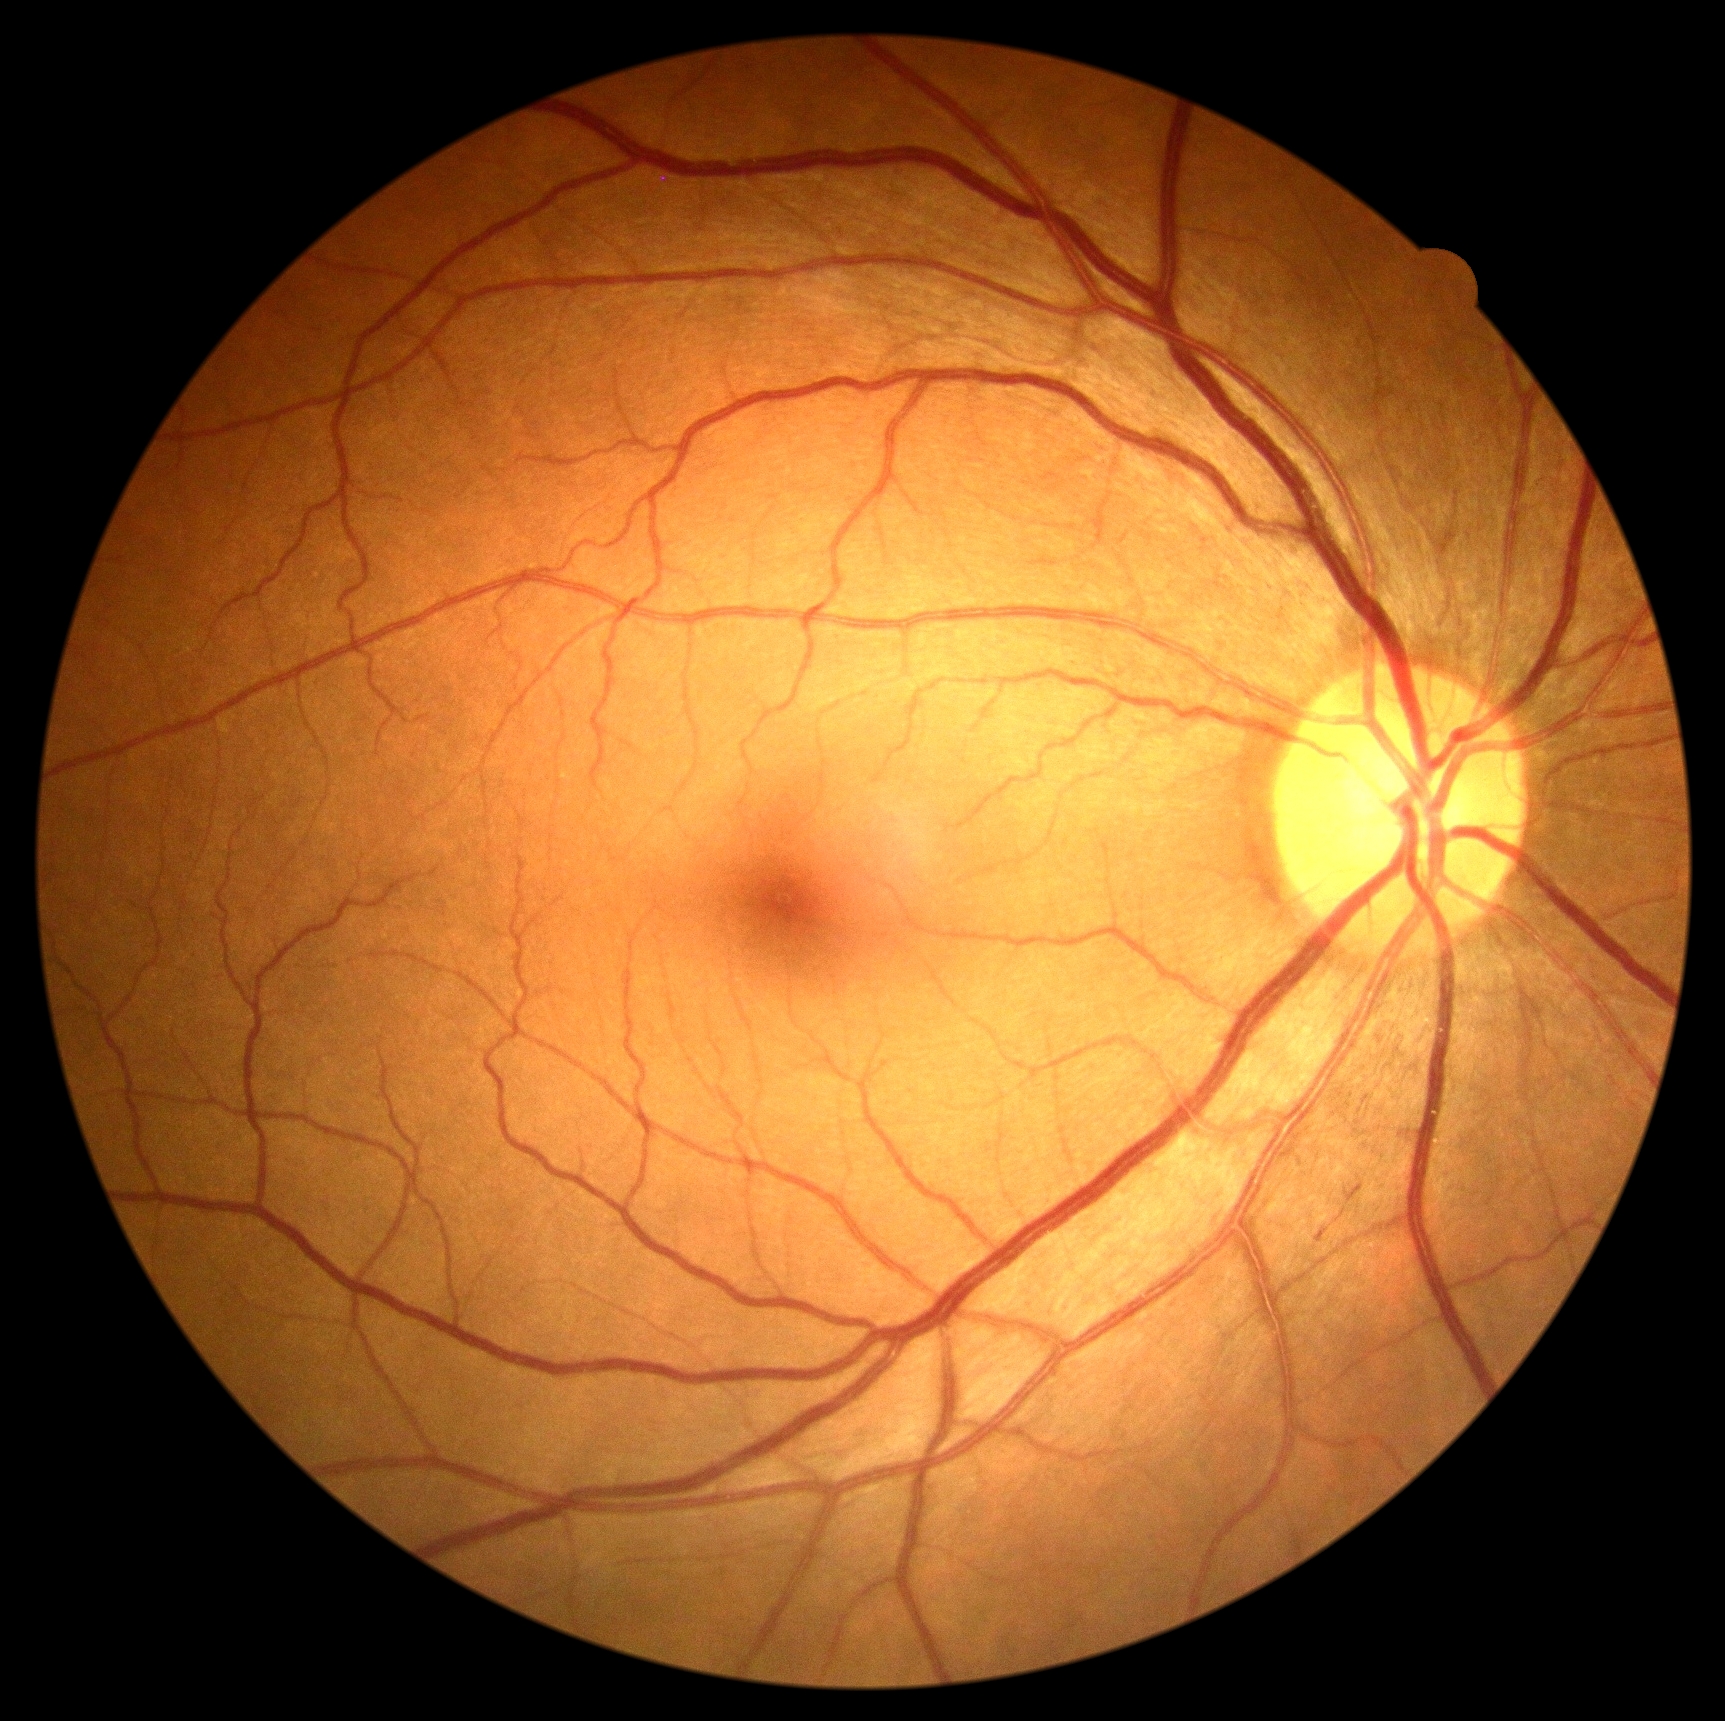 DR severity is 2/4. The retinopathy is classified as non-proliferative diabetic retinopathy.